848 by 848 pixels; nonmydriatic.
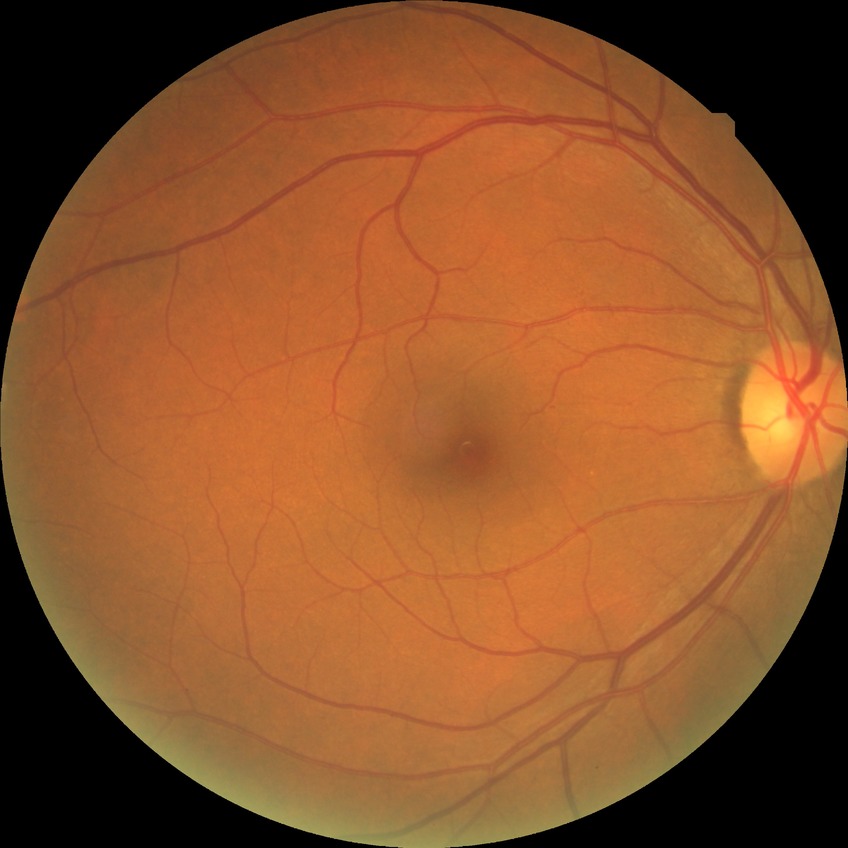
Diabetic retinopathy (DR): NDR (no diabetic retinopathy).